45° FOV; modified Davis grading; without pupil dilation:
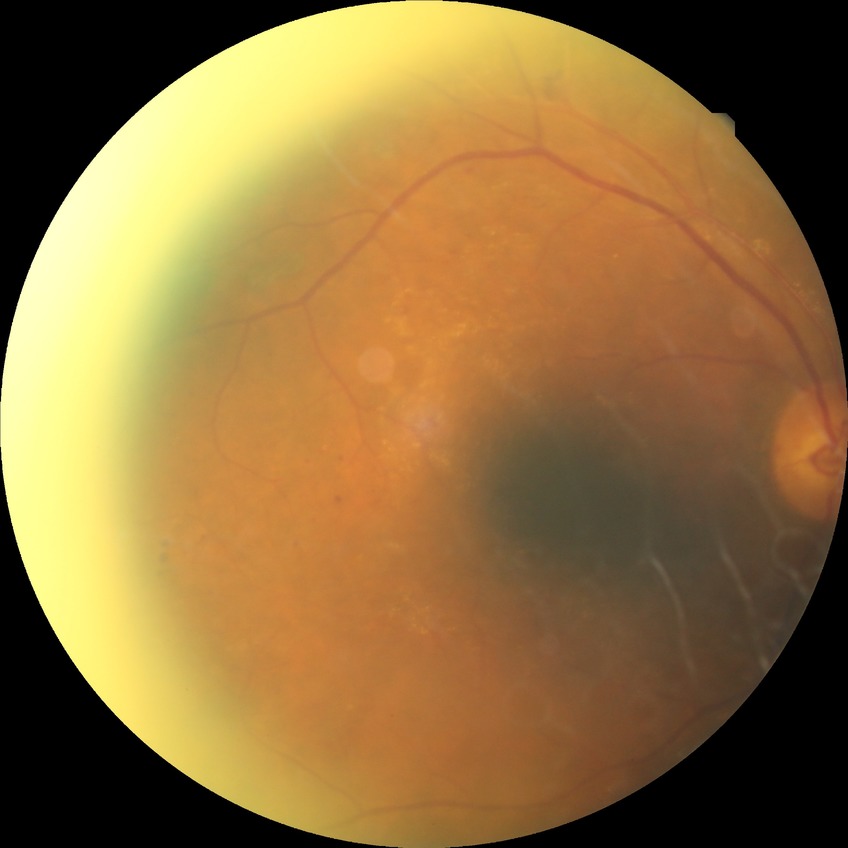 diabetic retinopathy (DR): proliferative diabetic retinopathy (PDR)